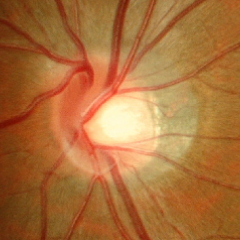

Glaucoma stage = no evidence of glaucoma.